2048x1536, 45° field of view, retinal fundus photograph — 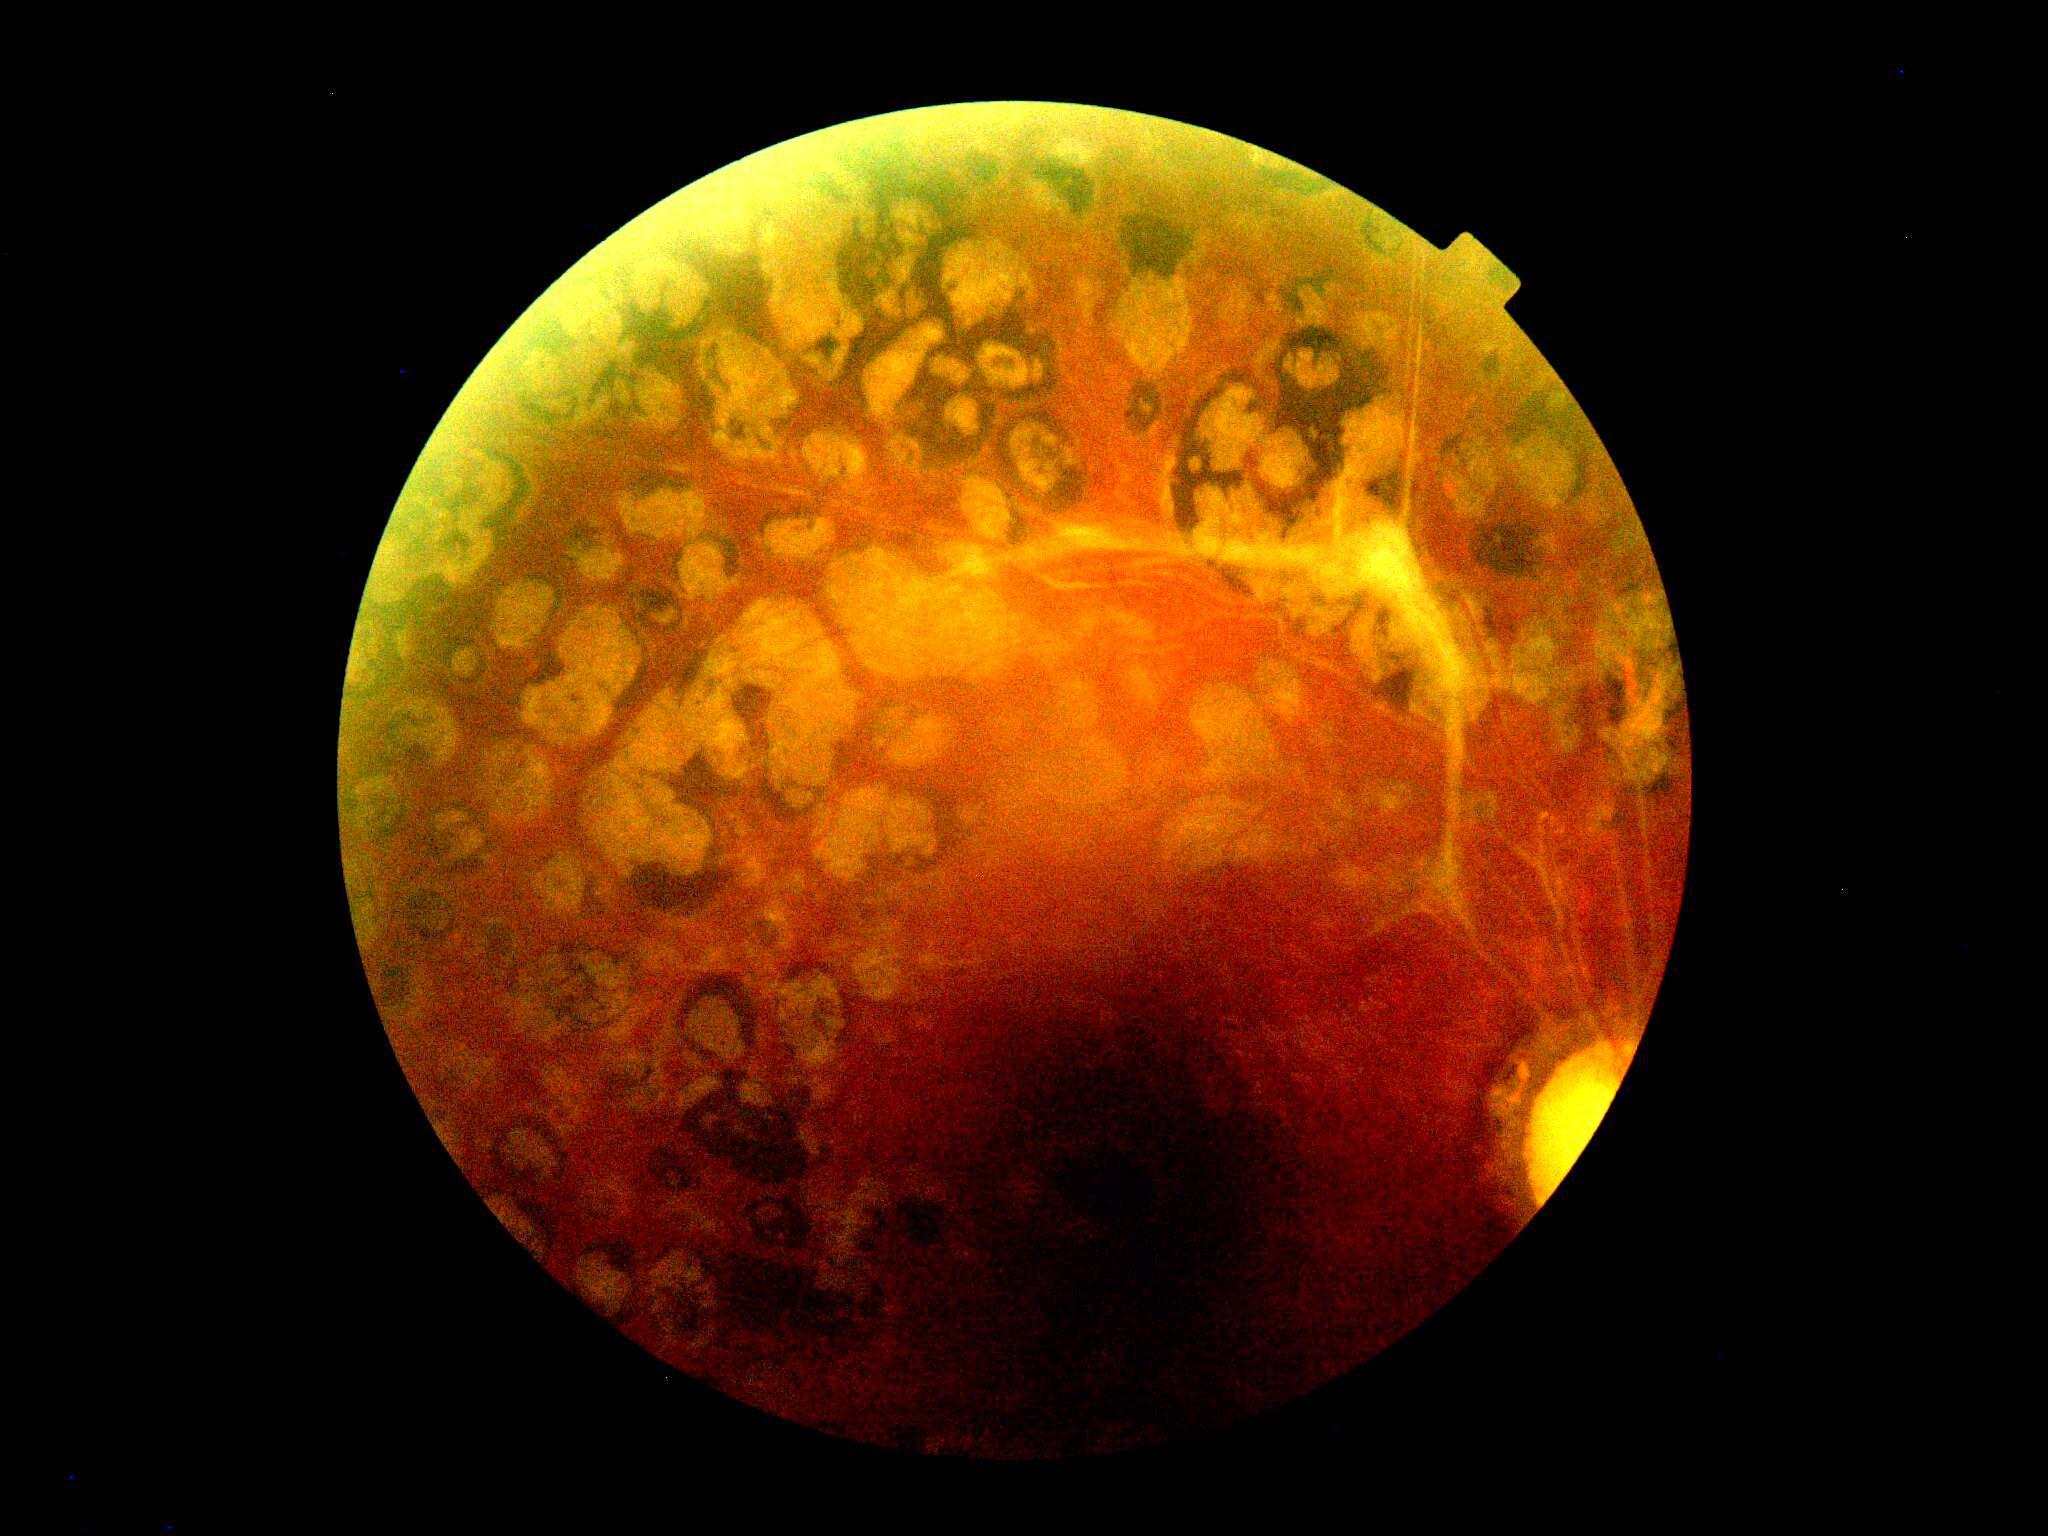

Disease class: proliferative diabetic retinopathy. Retinopathy grade is PDR (4).